Image size 848x848 · Davis DR grading.
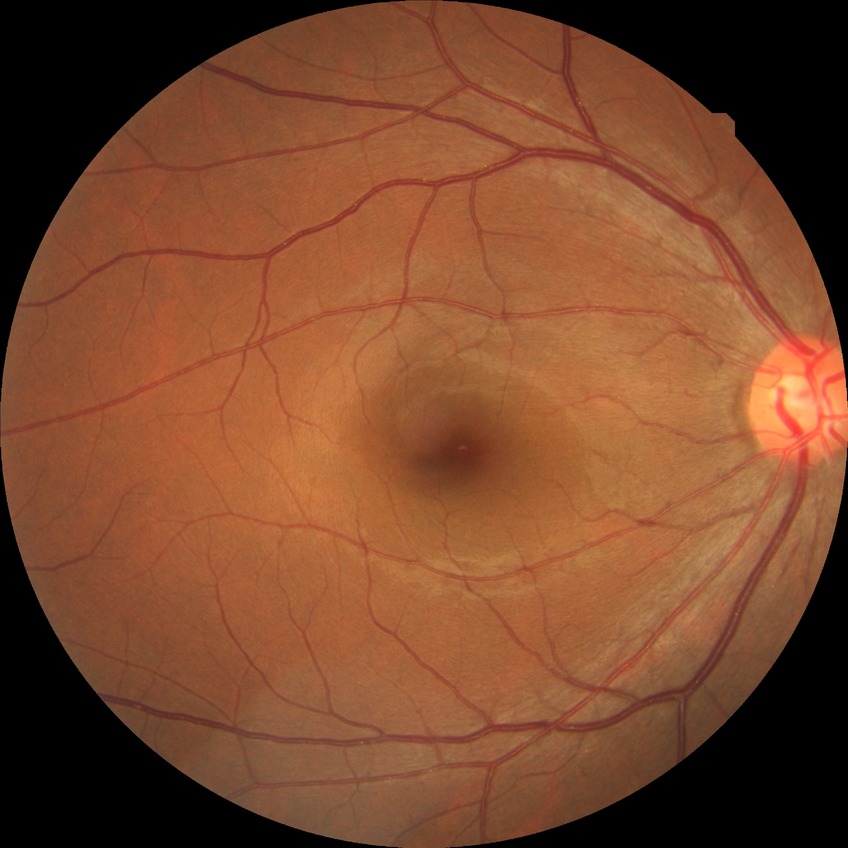
- diabetic retinopathy (DR) — no diabetic retinopathy (NDR)